Wide-field fundus photograph from neonatal ROP screening — 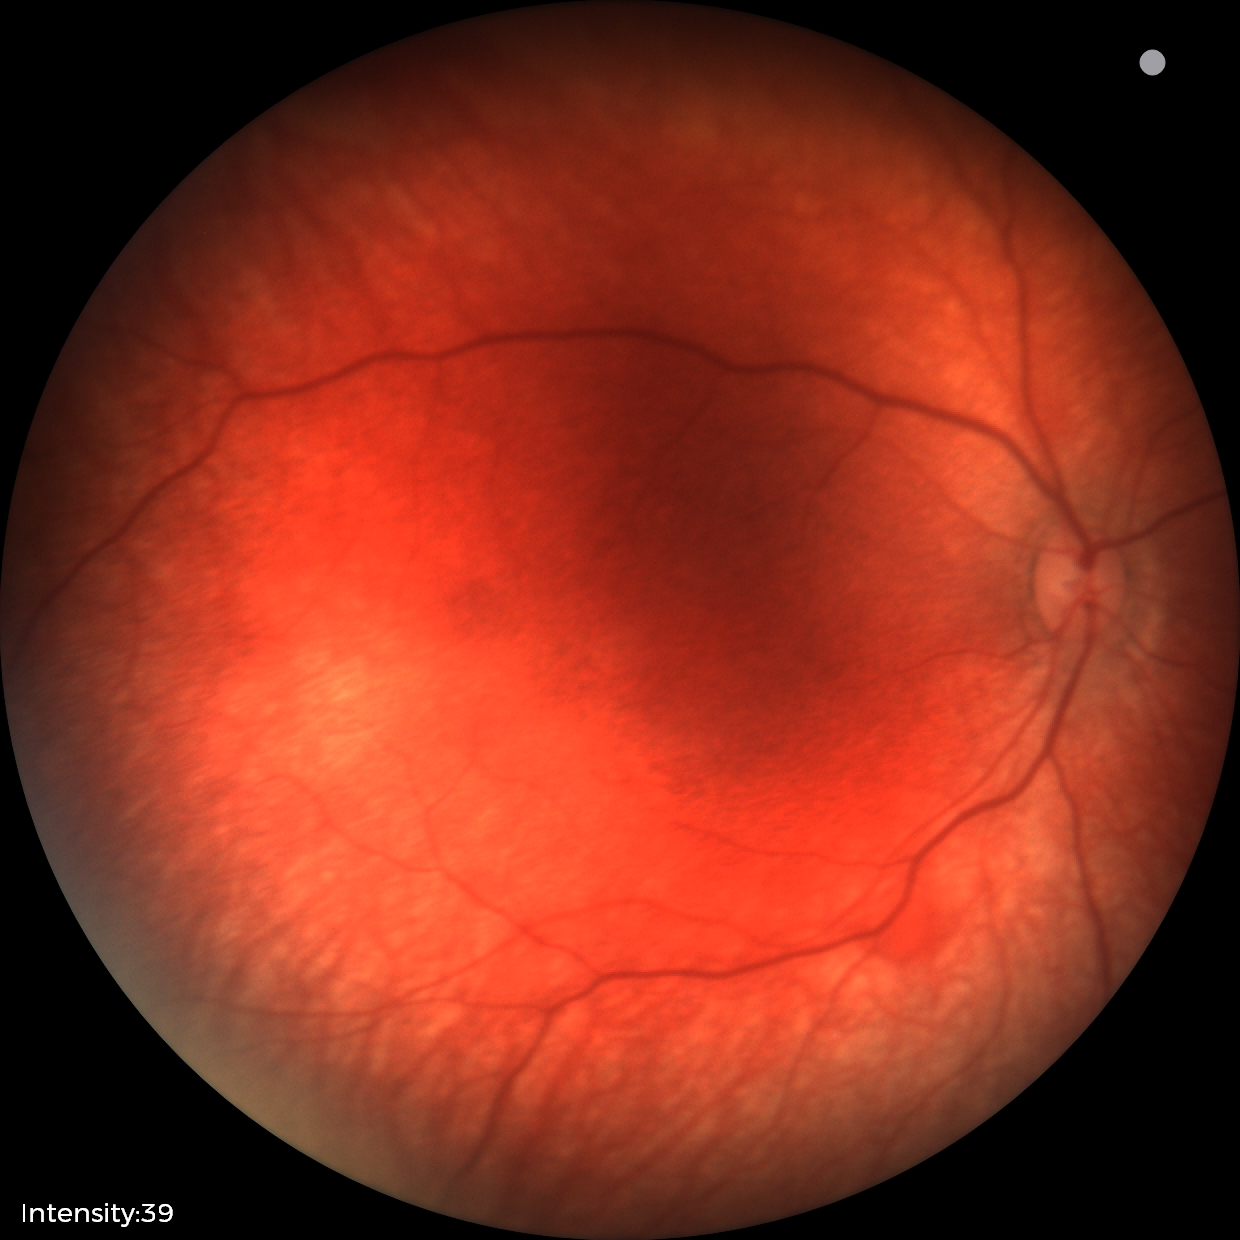

Q: What is the diagnosis from this examination?
A: retinal hemorrhages